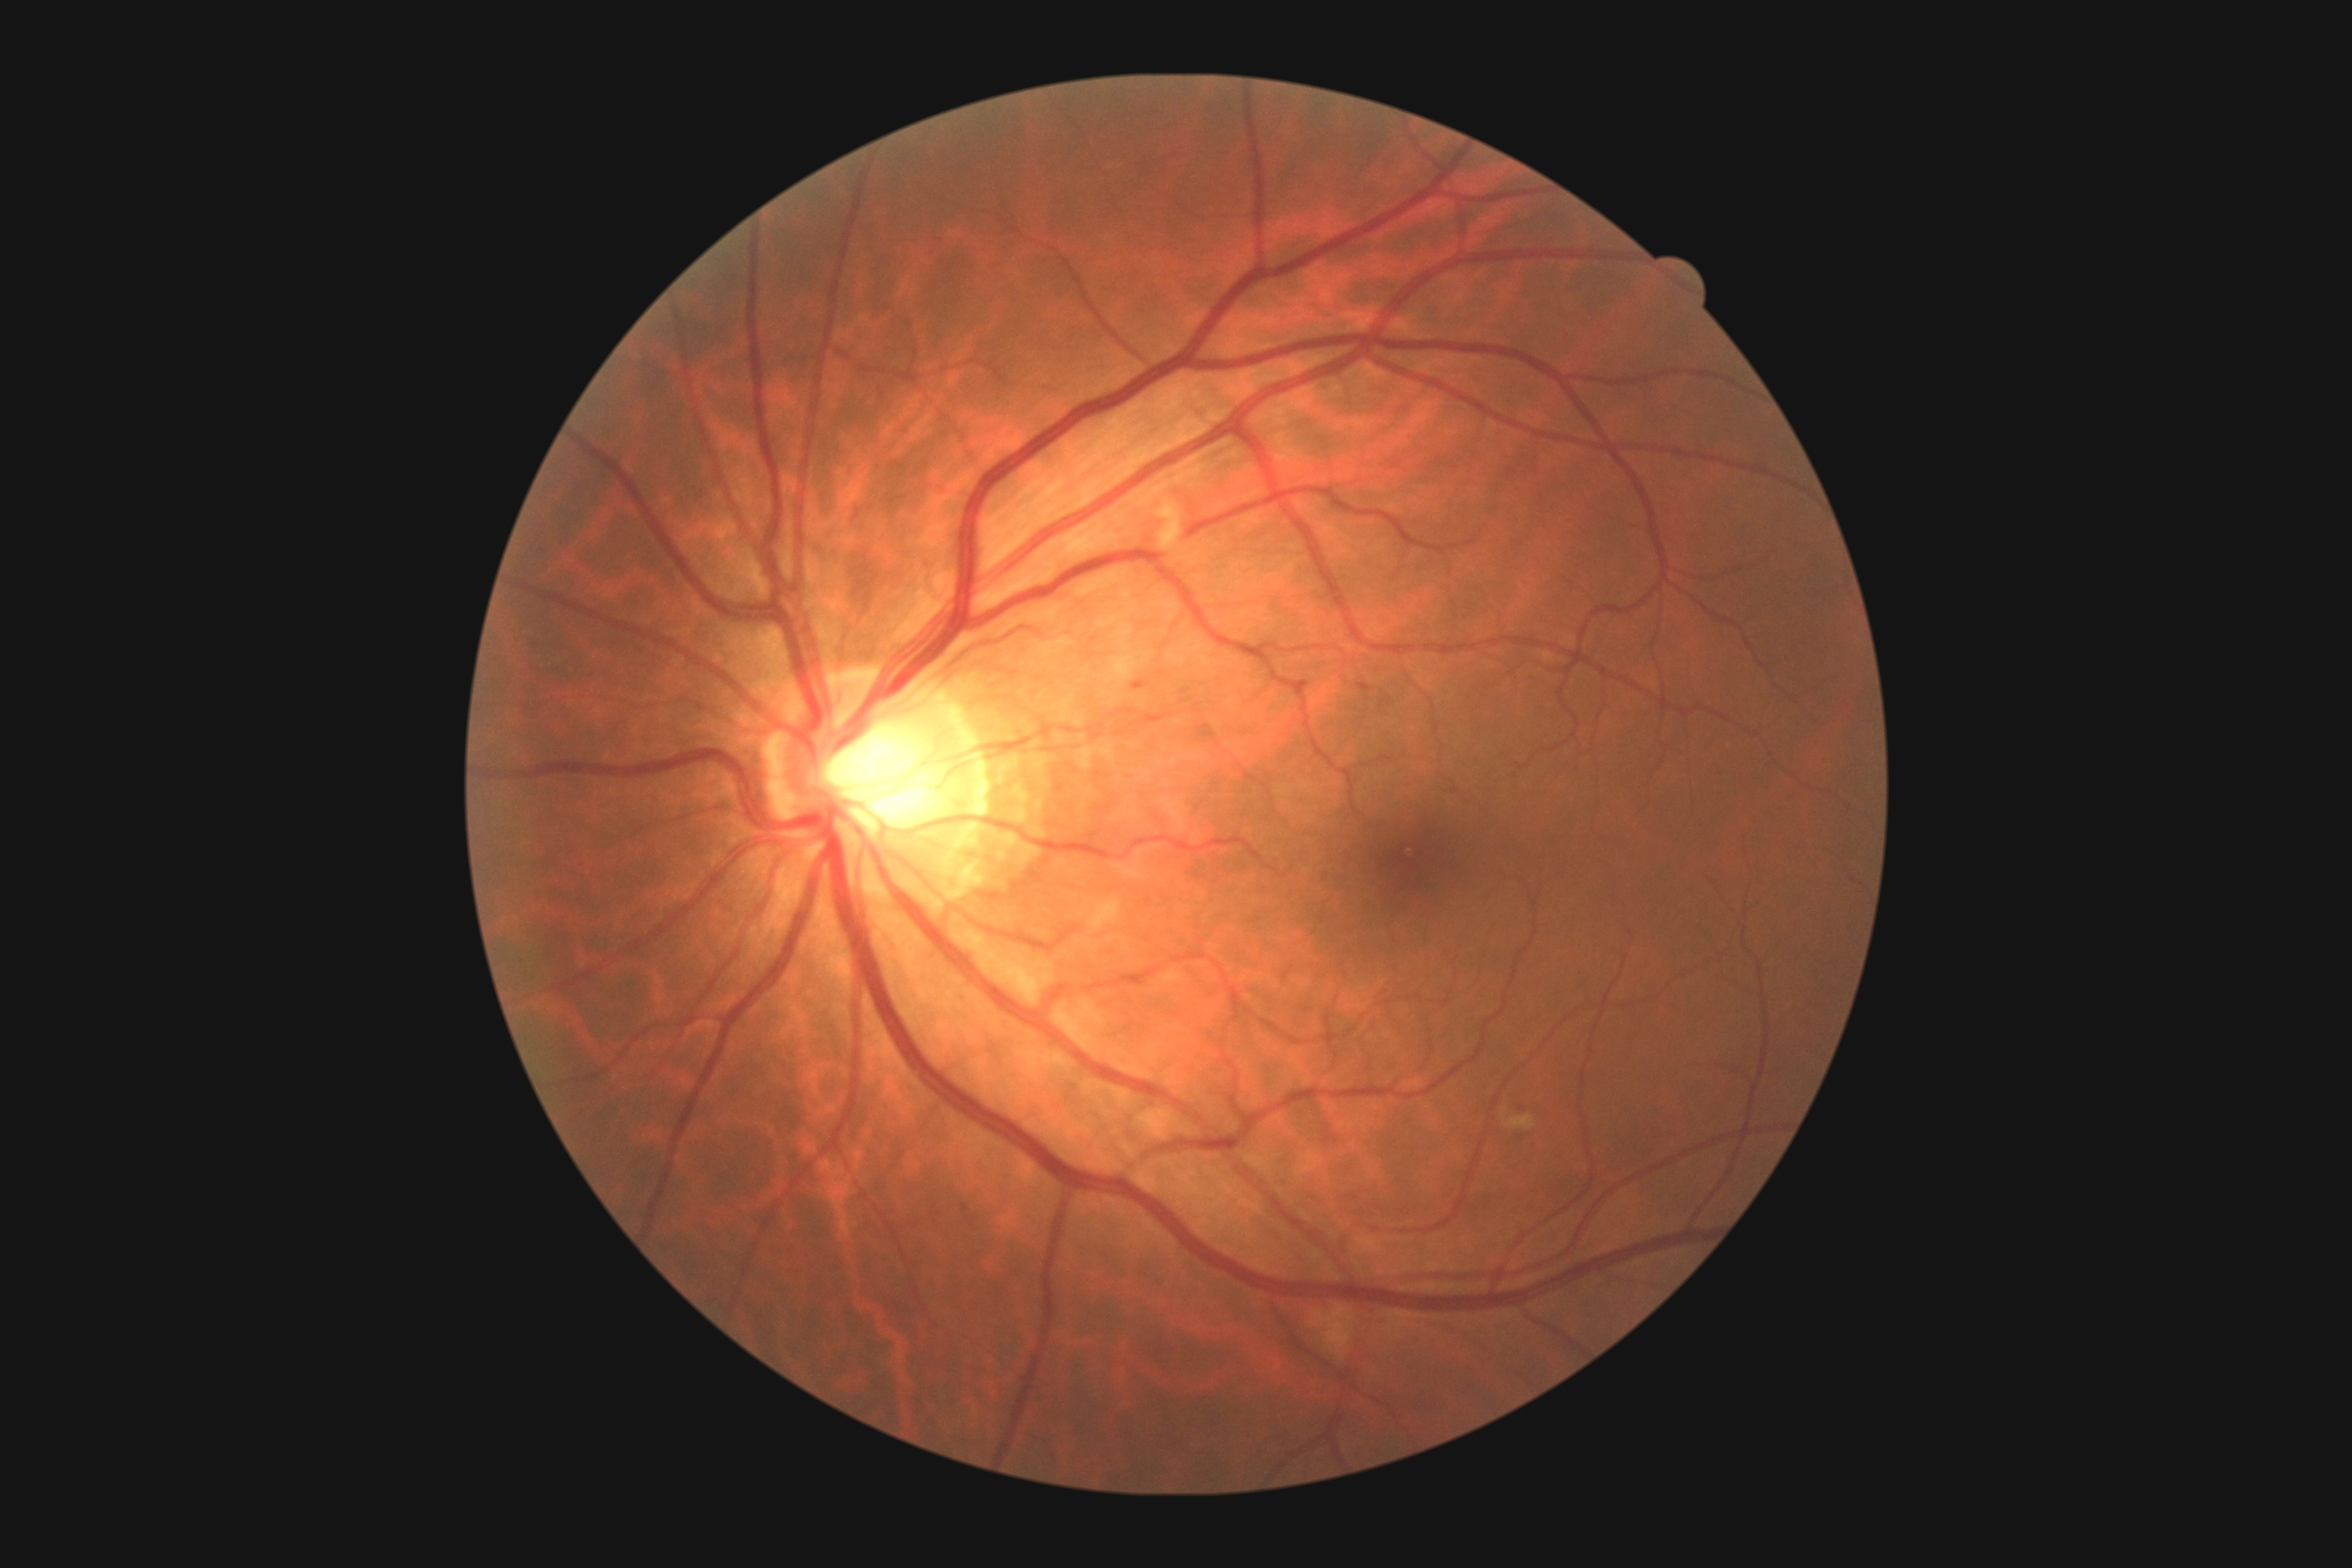
diabetic retinopathy severity: 2 — more than just microaneurysms but less than severe NPDR, DR class: non-proliferative diabetic retinopathy.